Non-mydriatic. Color fundus photograph
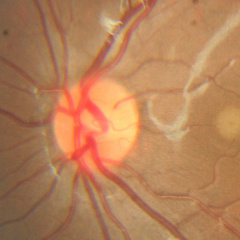 No signs of glaucoma.